Portable fundus photograph:
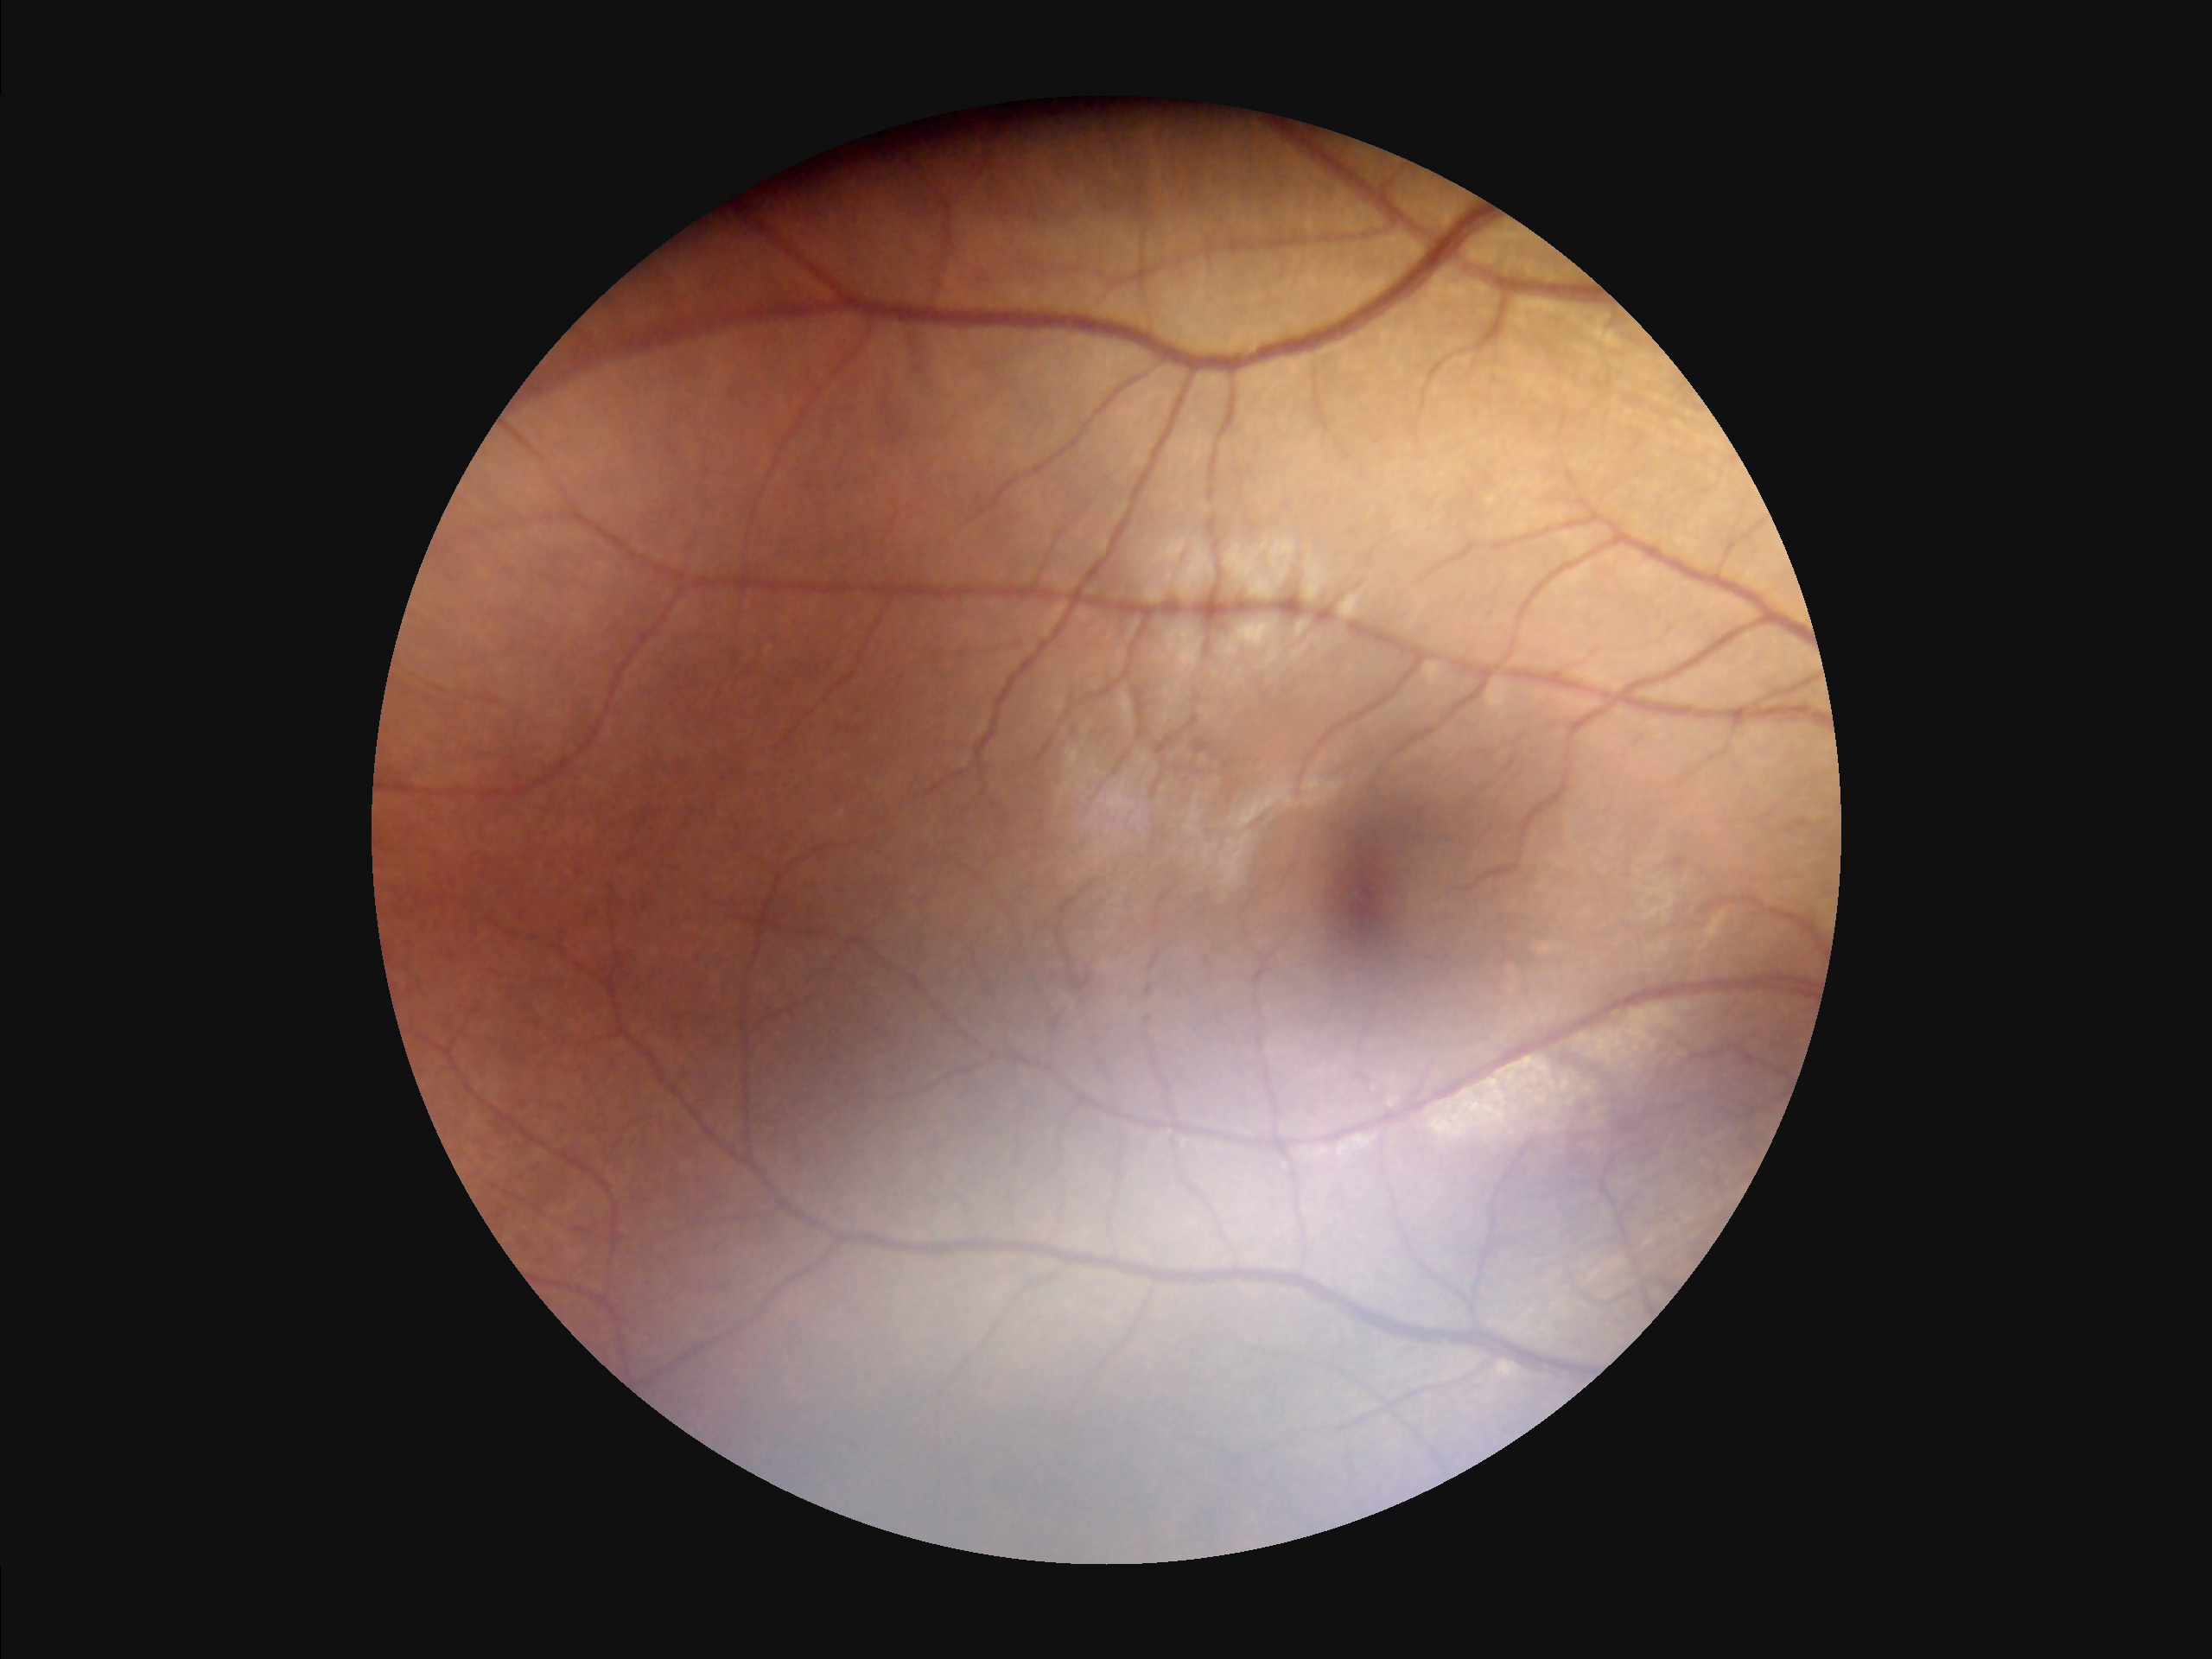
Contrast is good. Illumination and color are suboptimal. Image is sharp throughout the field.